100° field of view (Phoenix ICON); pediatric retinal photograph (wide-field); 1240 by 1240 pixels.
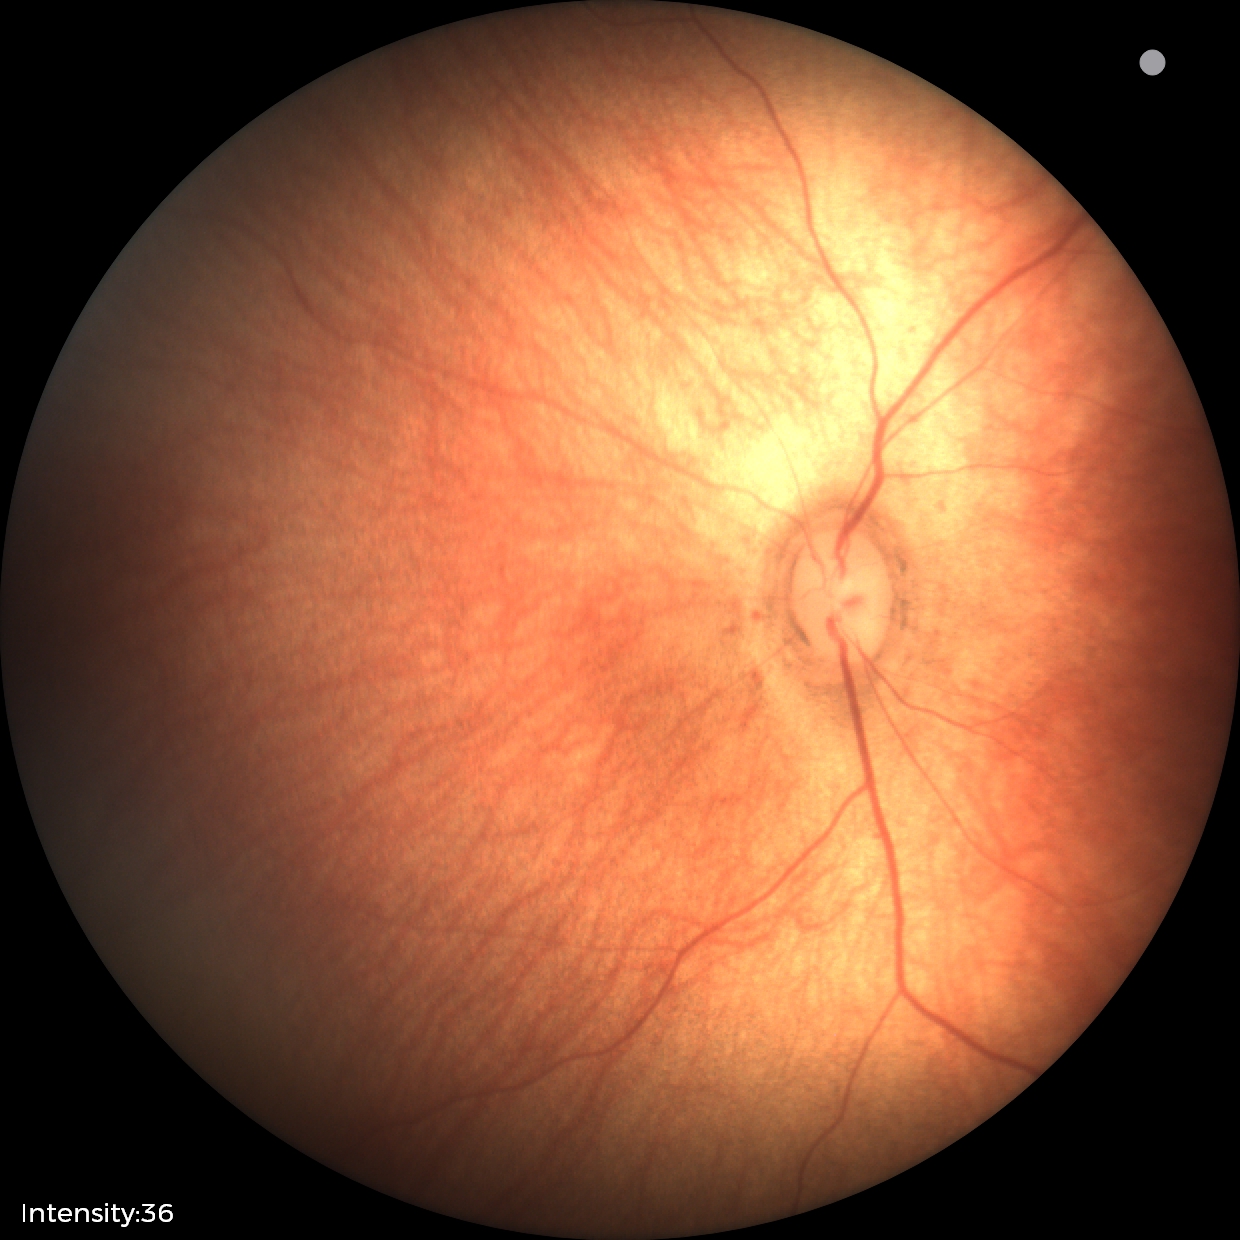 No retinal pathology identified on screening.